Wide-field fundus photograph from neonatal ROP screening.
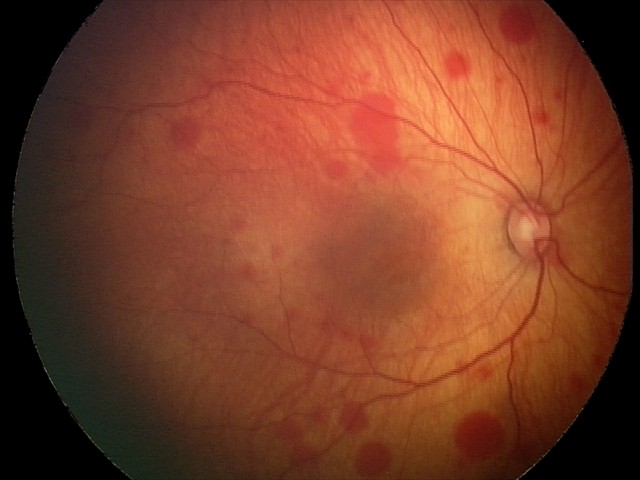
Screening examination consistent with retinal hemorrhages.